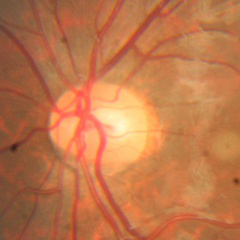 Glaucoma status: no evidence of glaucoma.